Captured with the Phoenix ICON (100° field of view) · wide-field fundus image from infant ROP screening · image size 1240x1240
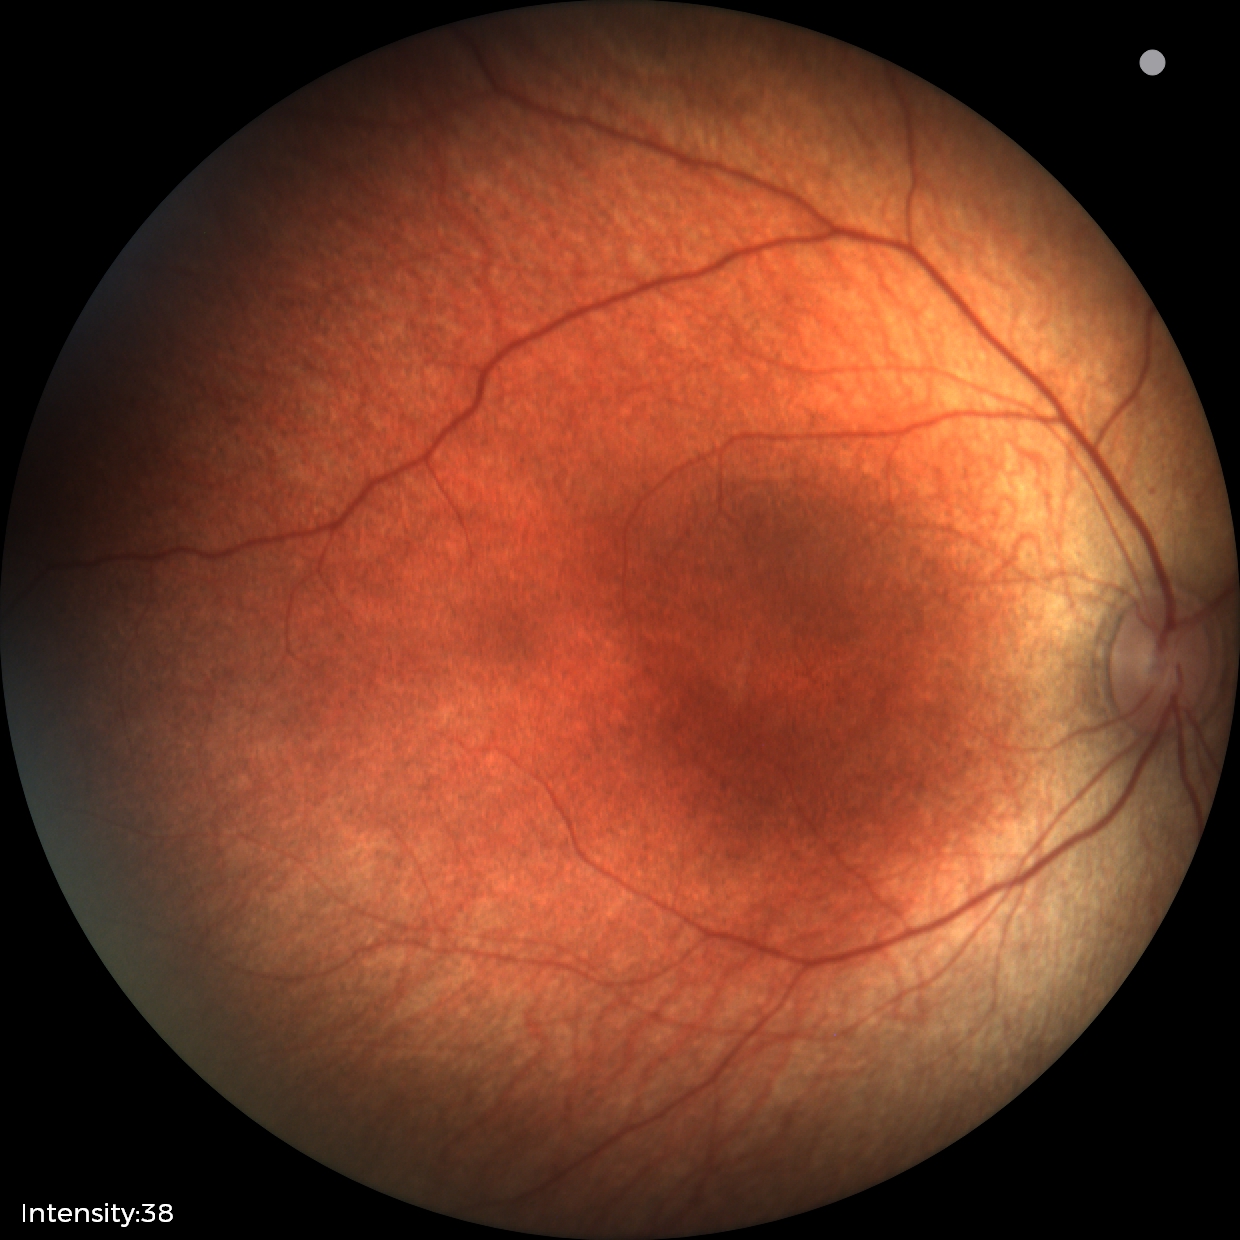

Impression: physiological retinal finding.